NIDEK AFC-230 fundus camera:
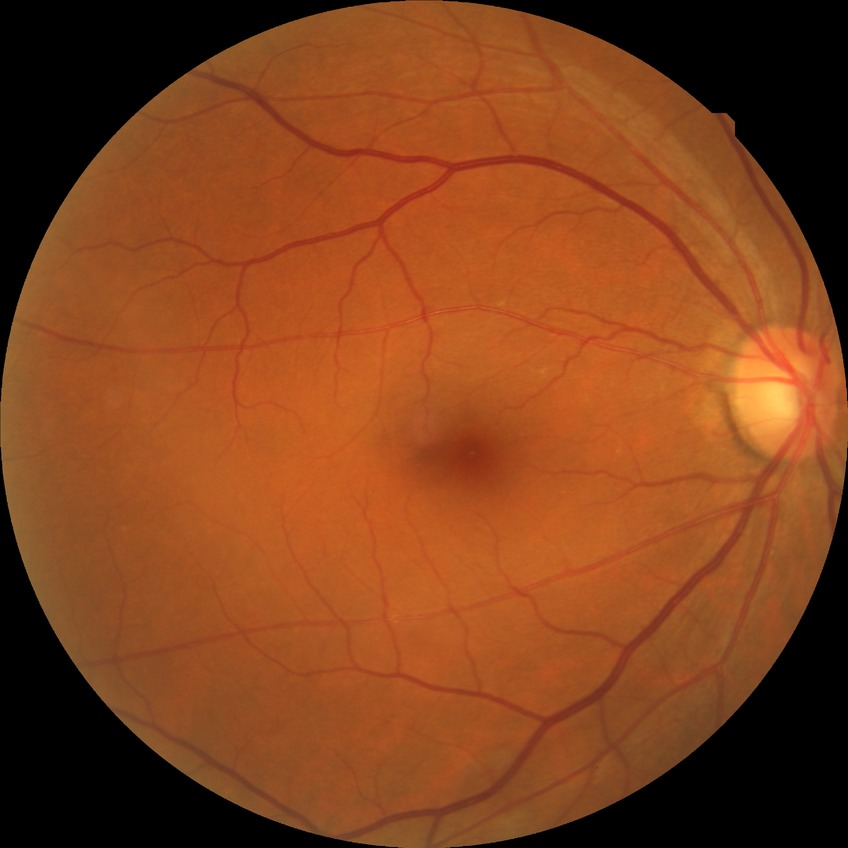

DR stage@NDR.